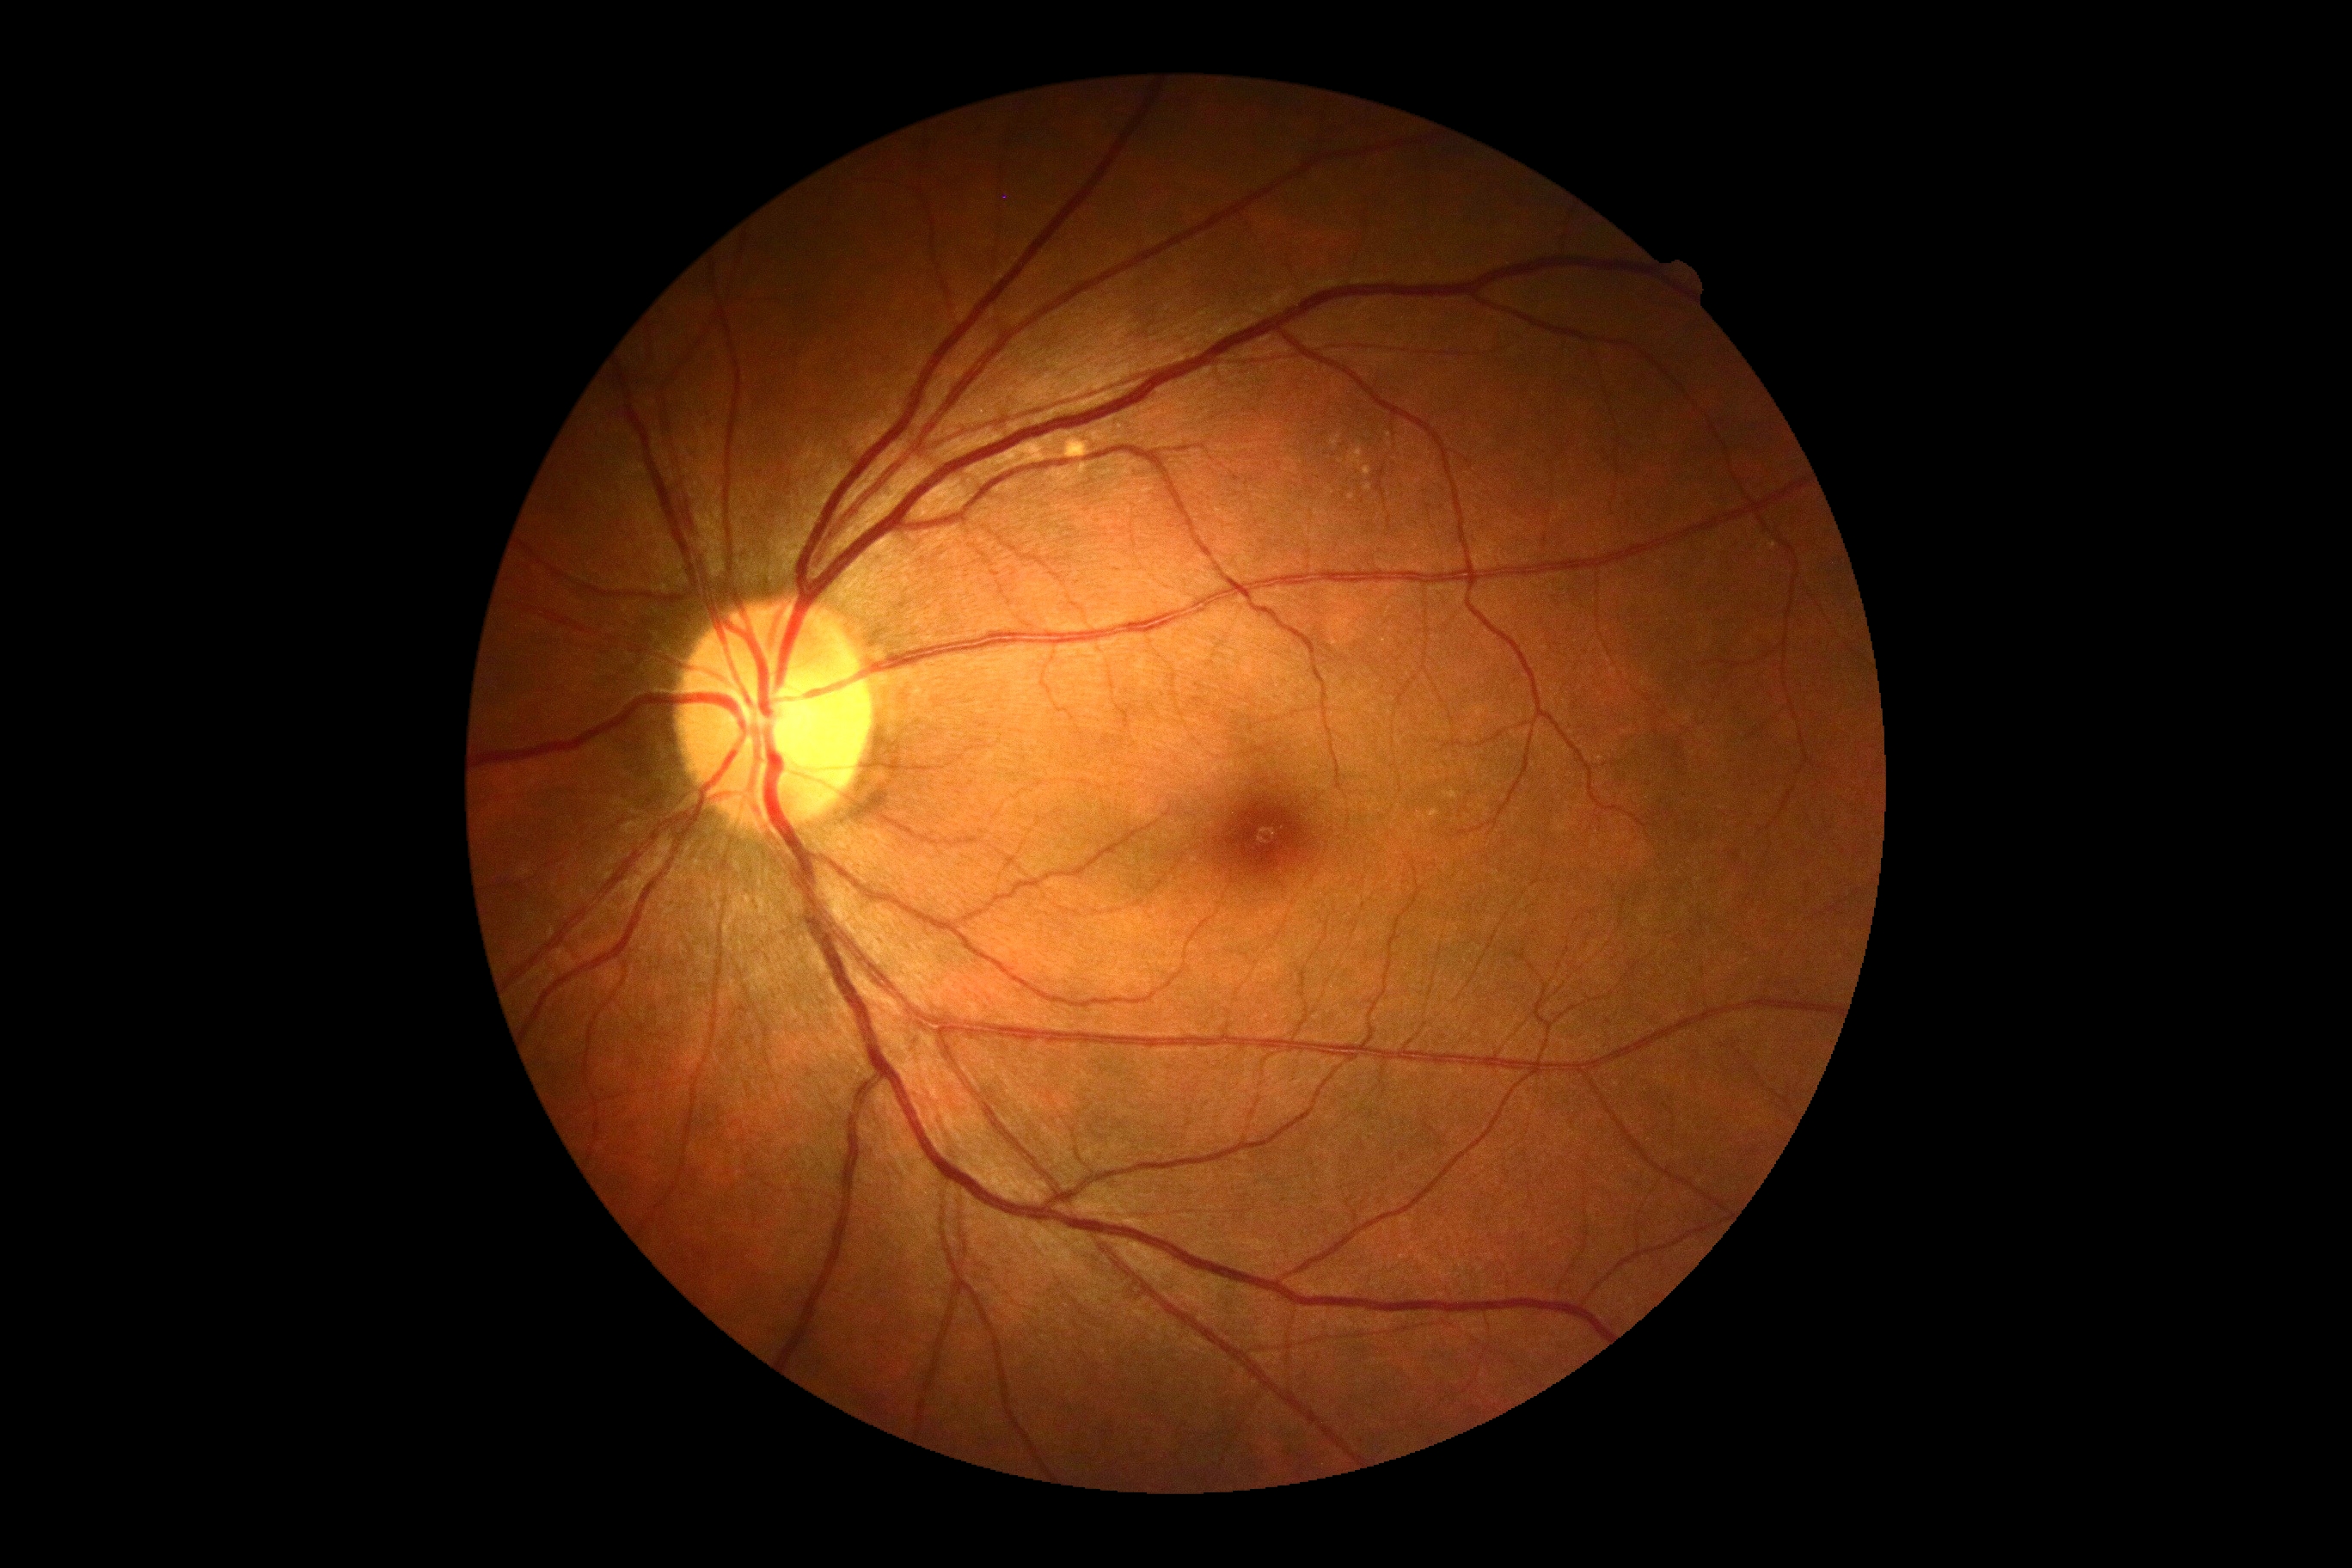
Diabetic retinopathy is 0/4.